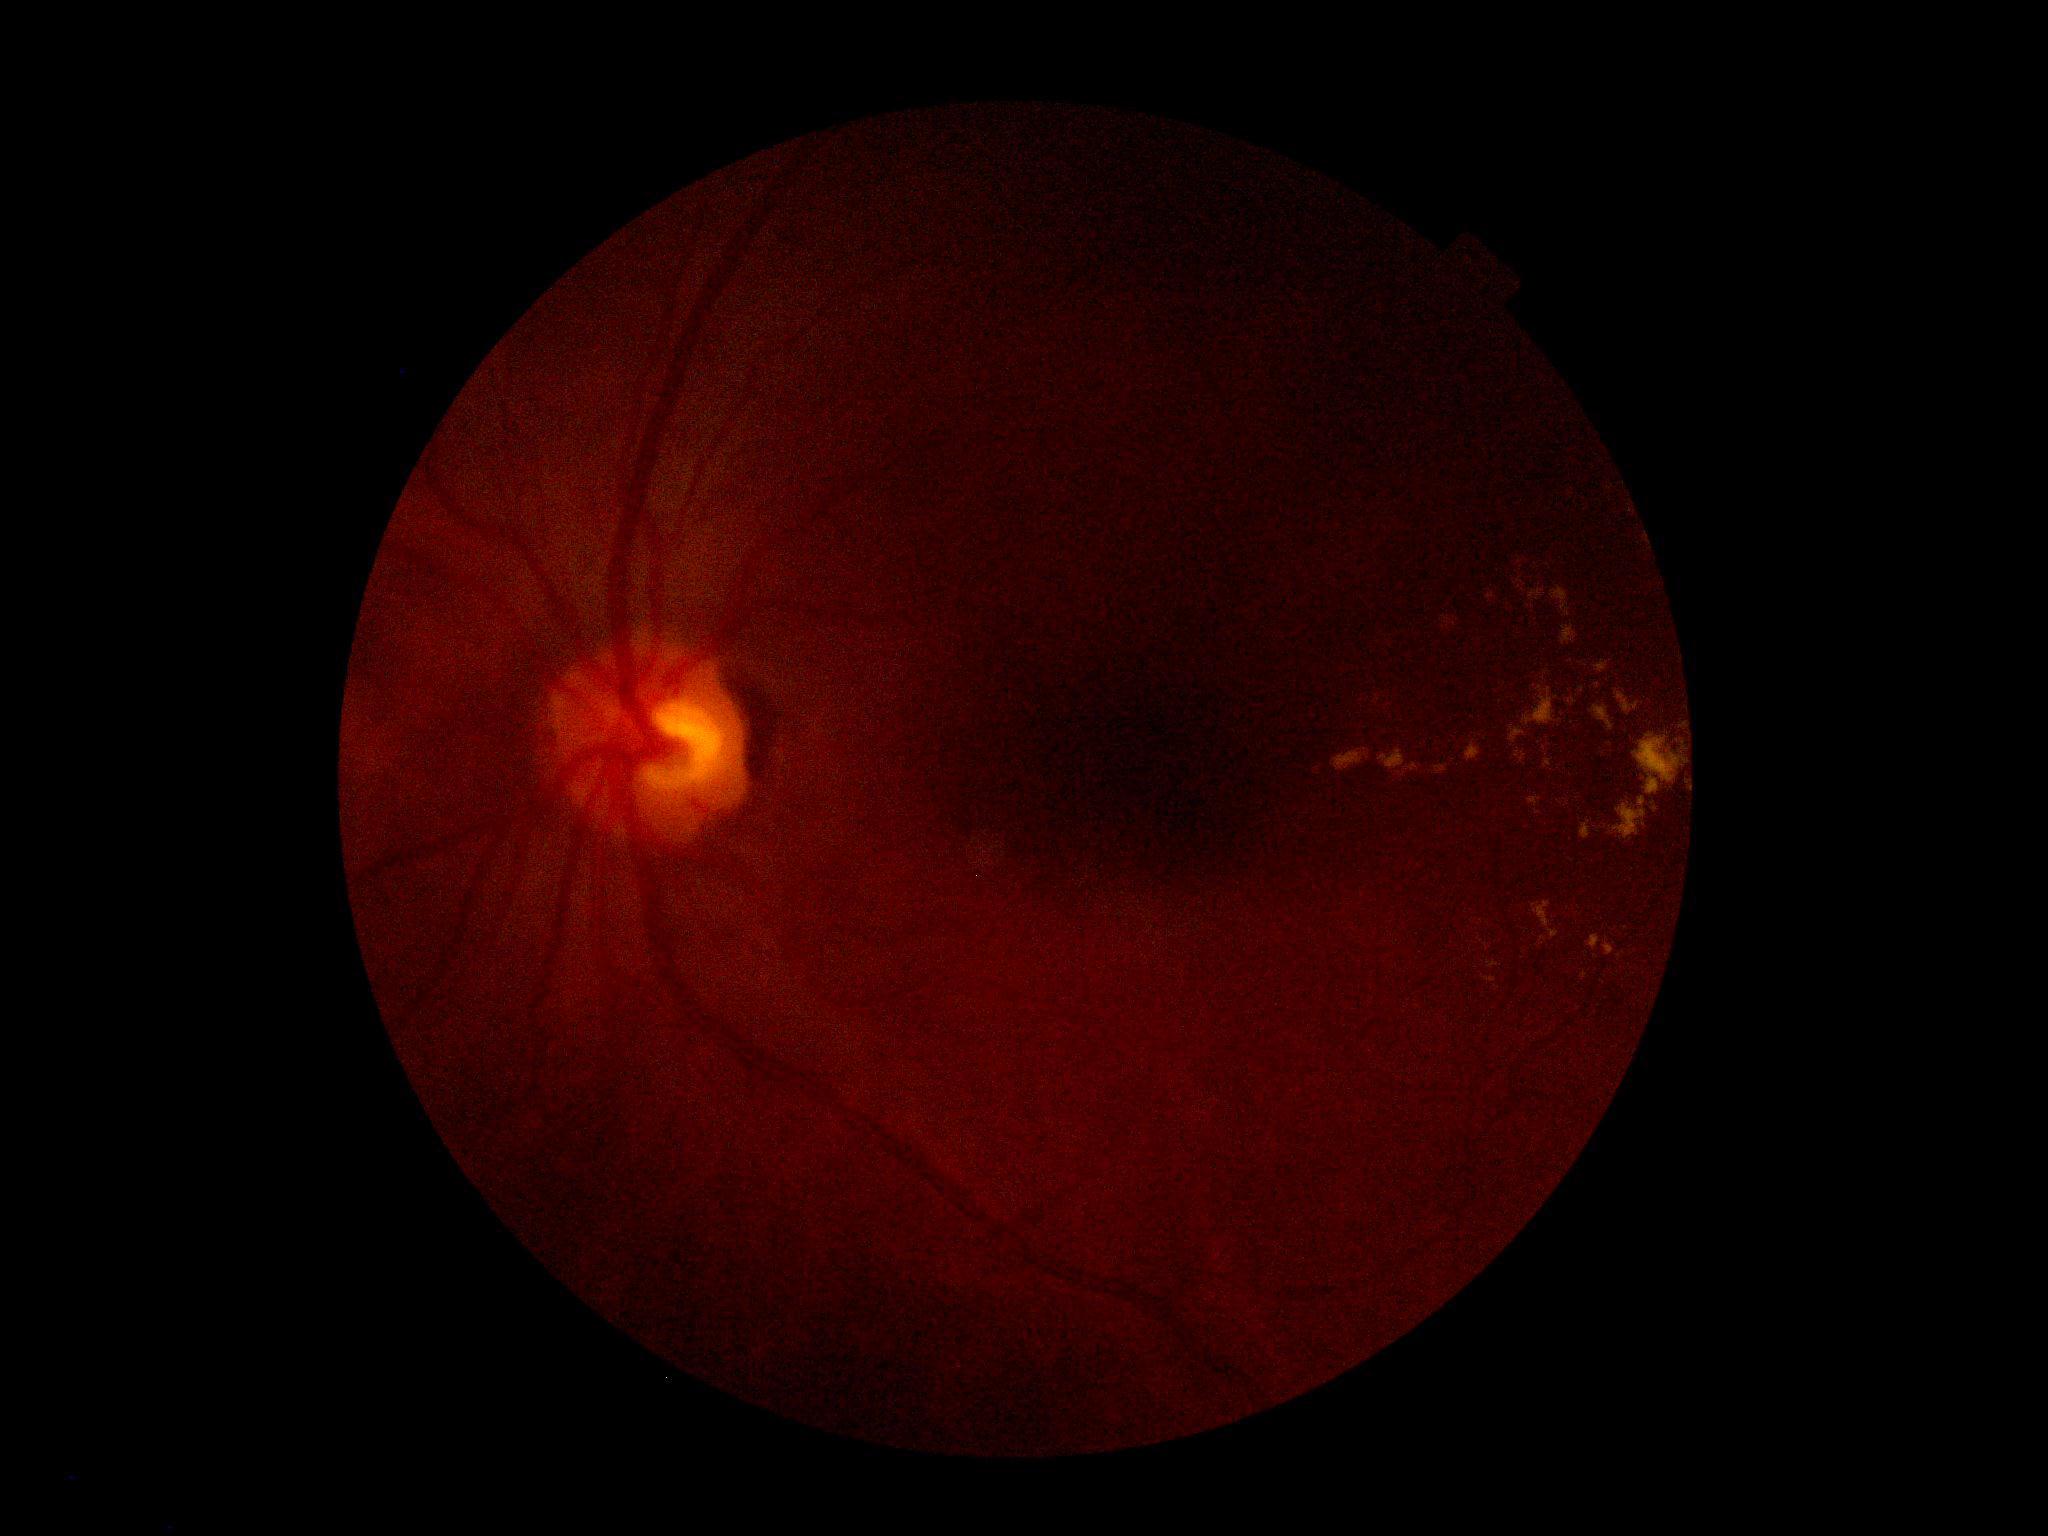 Diabetic retinopathy (DR) is grade 2 (moderate NPDR).